2352x1568 · fundus photo · 45° FOV: 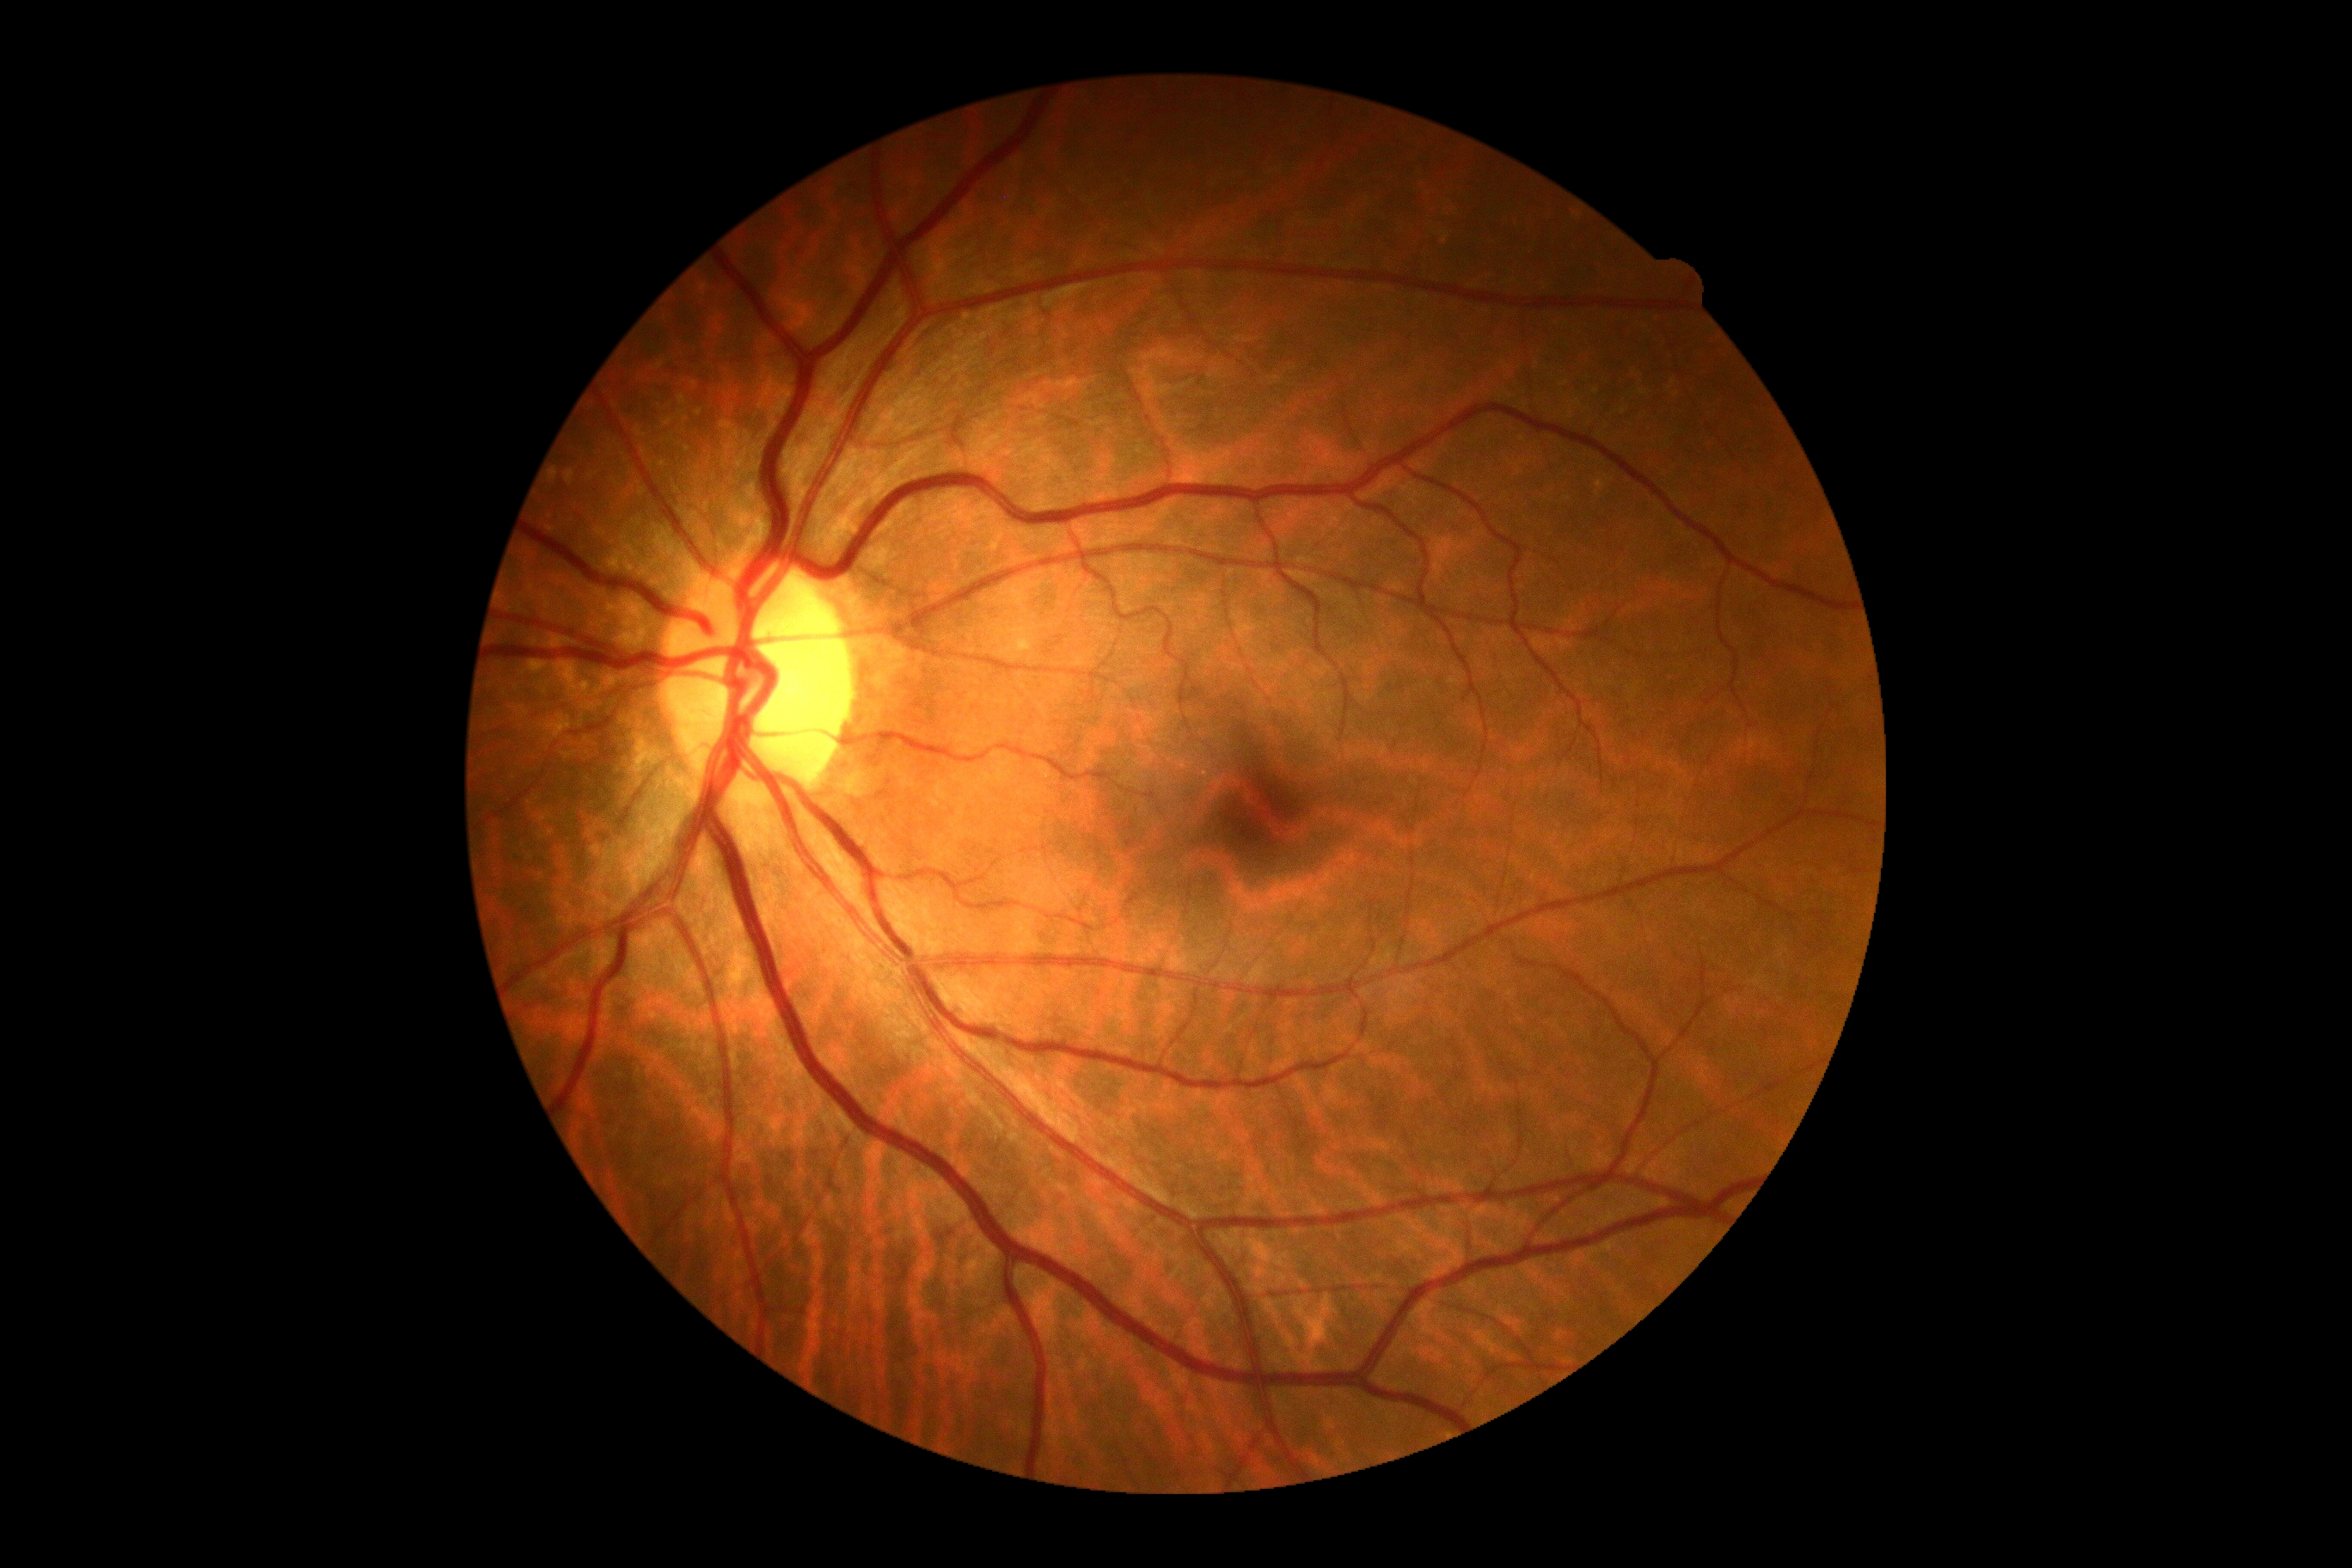
  dr_impression: negative for DR
  dr_grade: 0